Nonmydriatic
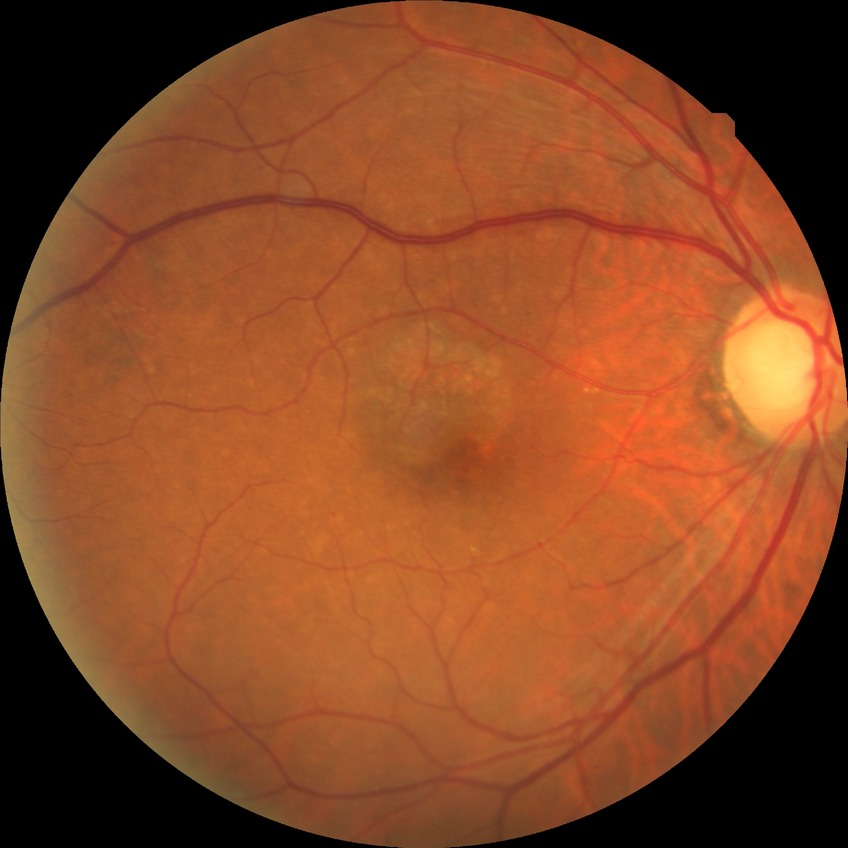
Davis grading: no diabetic retinopathy.